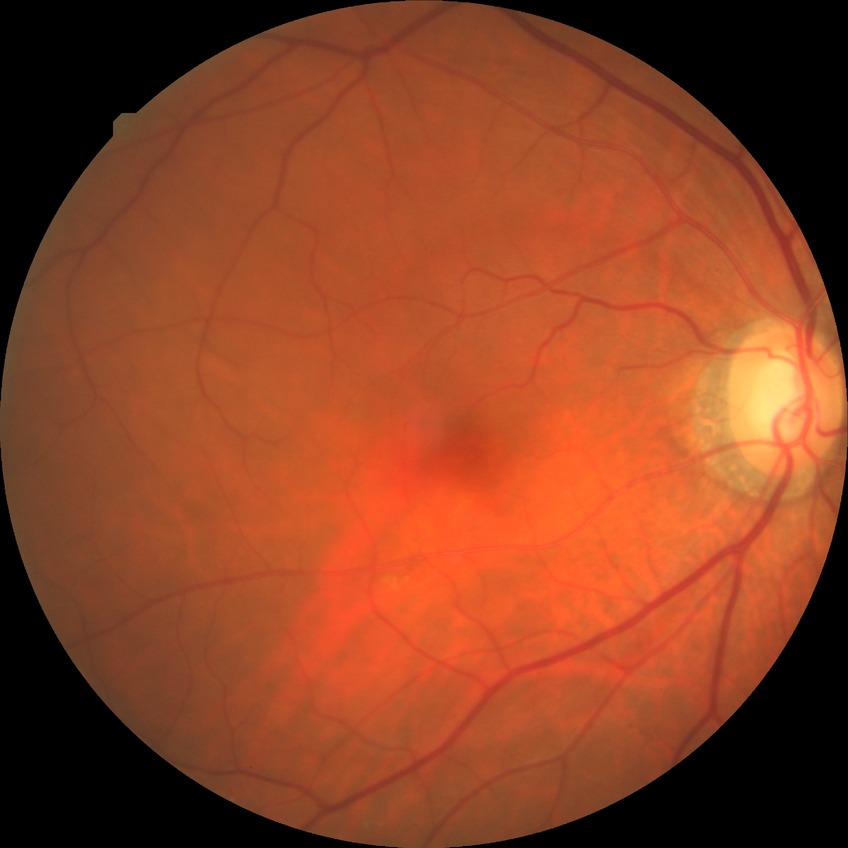 Diabetic retinopathy (DR) is NDR (no diabetic retinopathy).